Acquired with a Topcon TRC-NW8
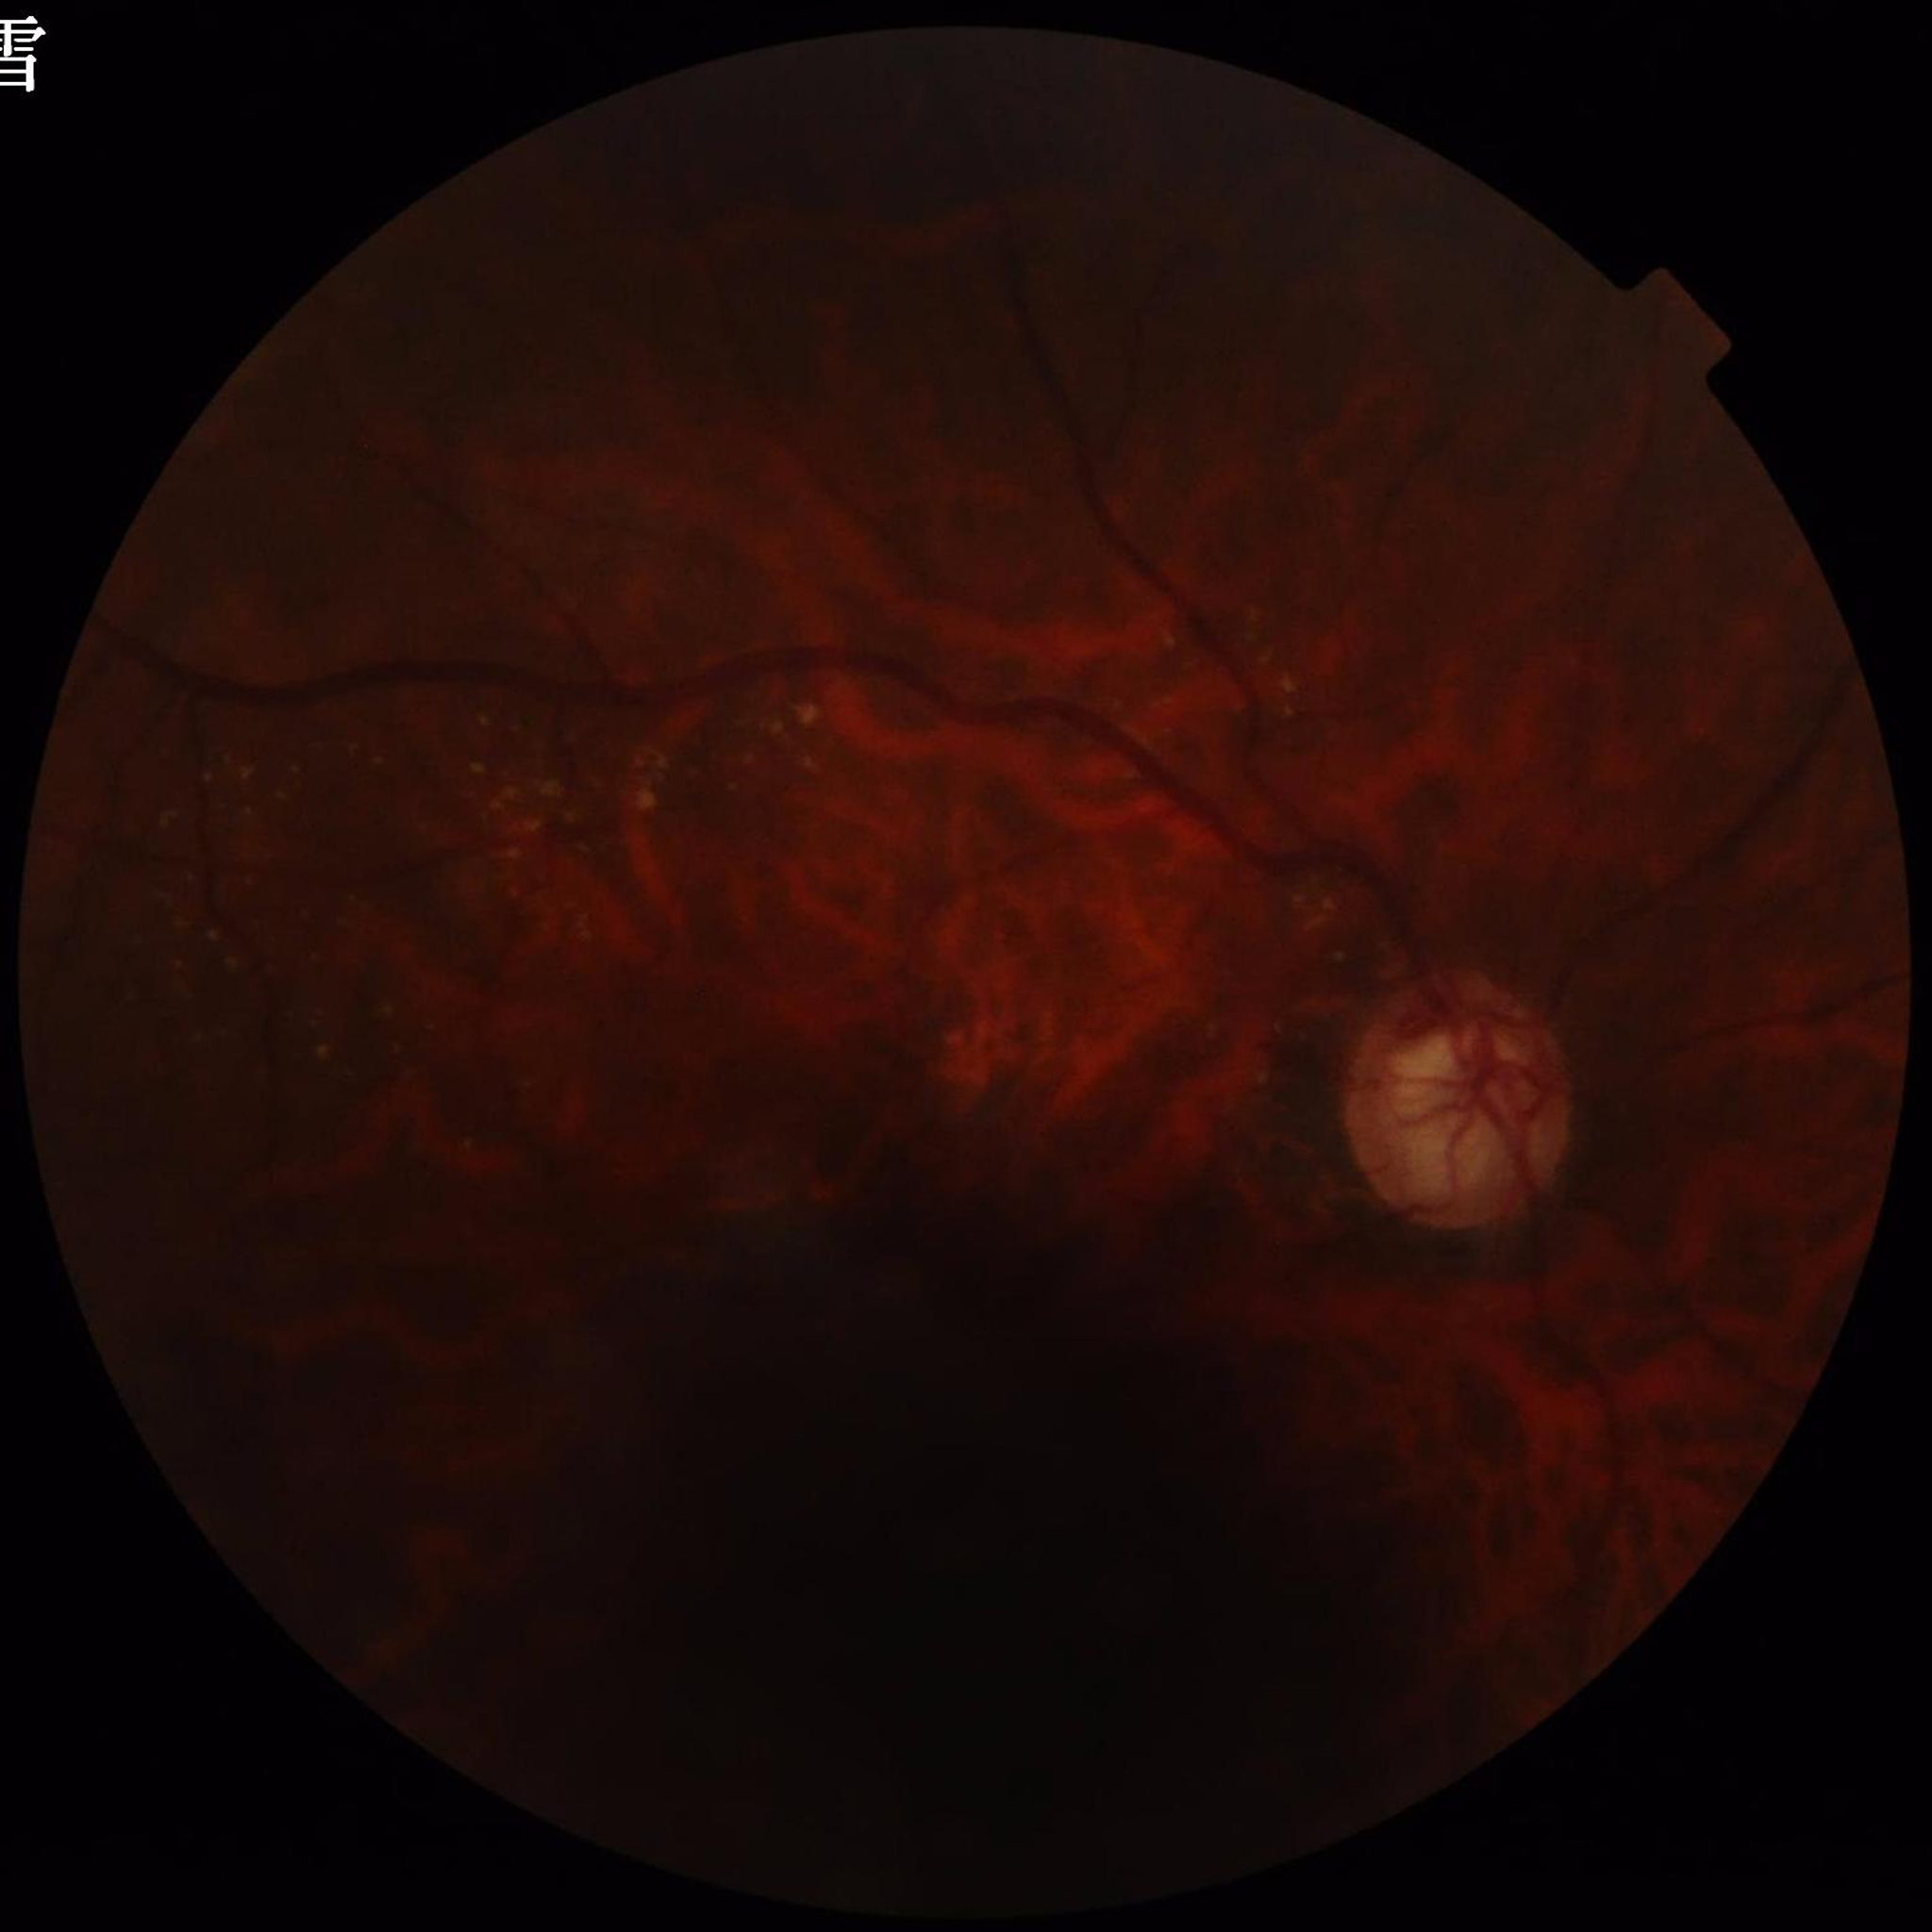 diagnosis: glaucoma
image_quality: reduced — illumination/color distortion, blur, low contrast